DR severity per modified Davis staging · no pharmacologic dilation:
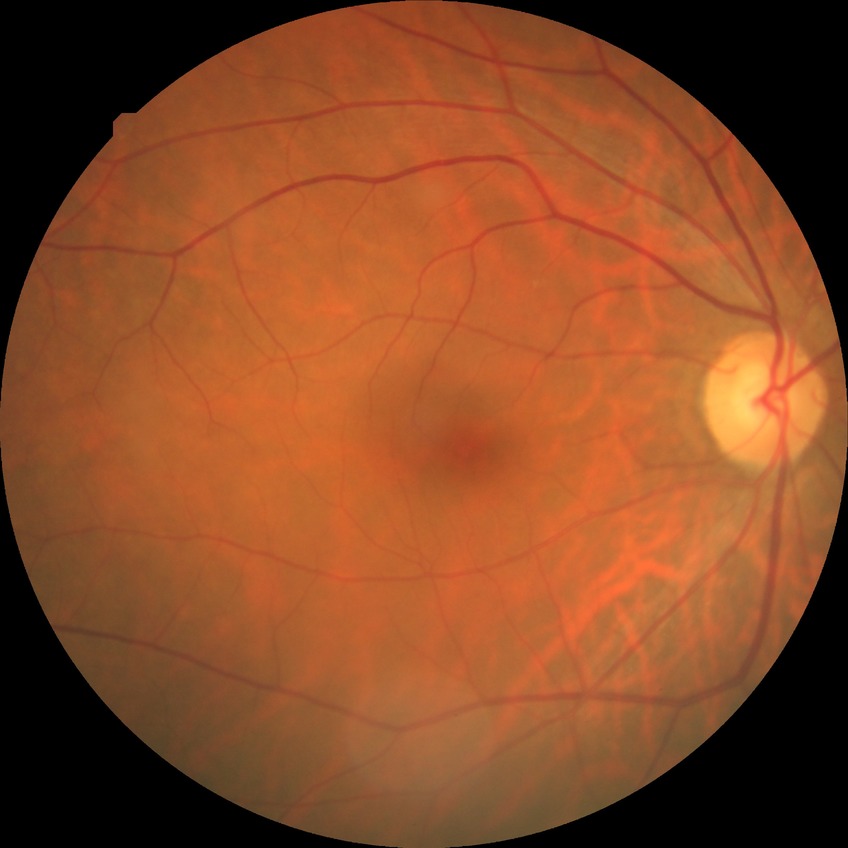

Annotations:
* modified Davis grade — NDR
* DR impression — negative for DR